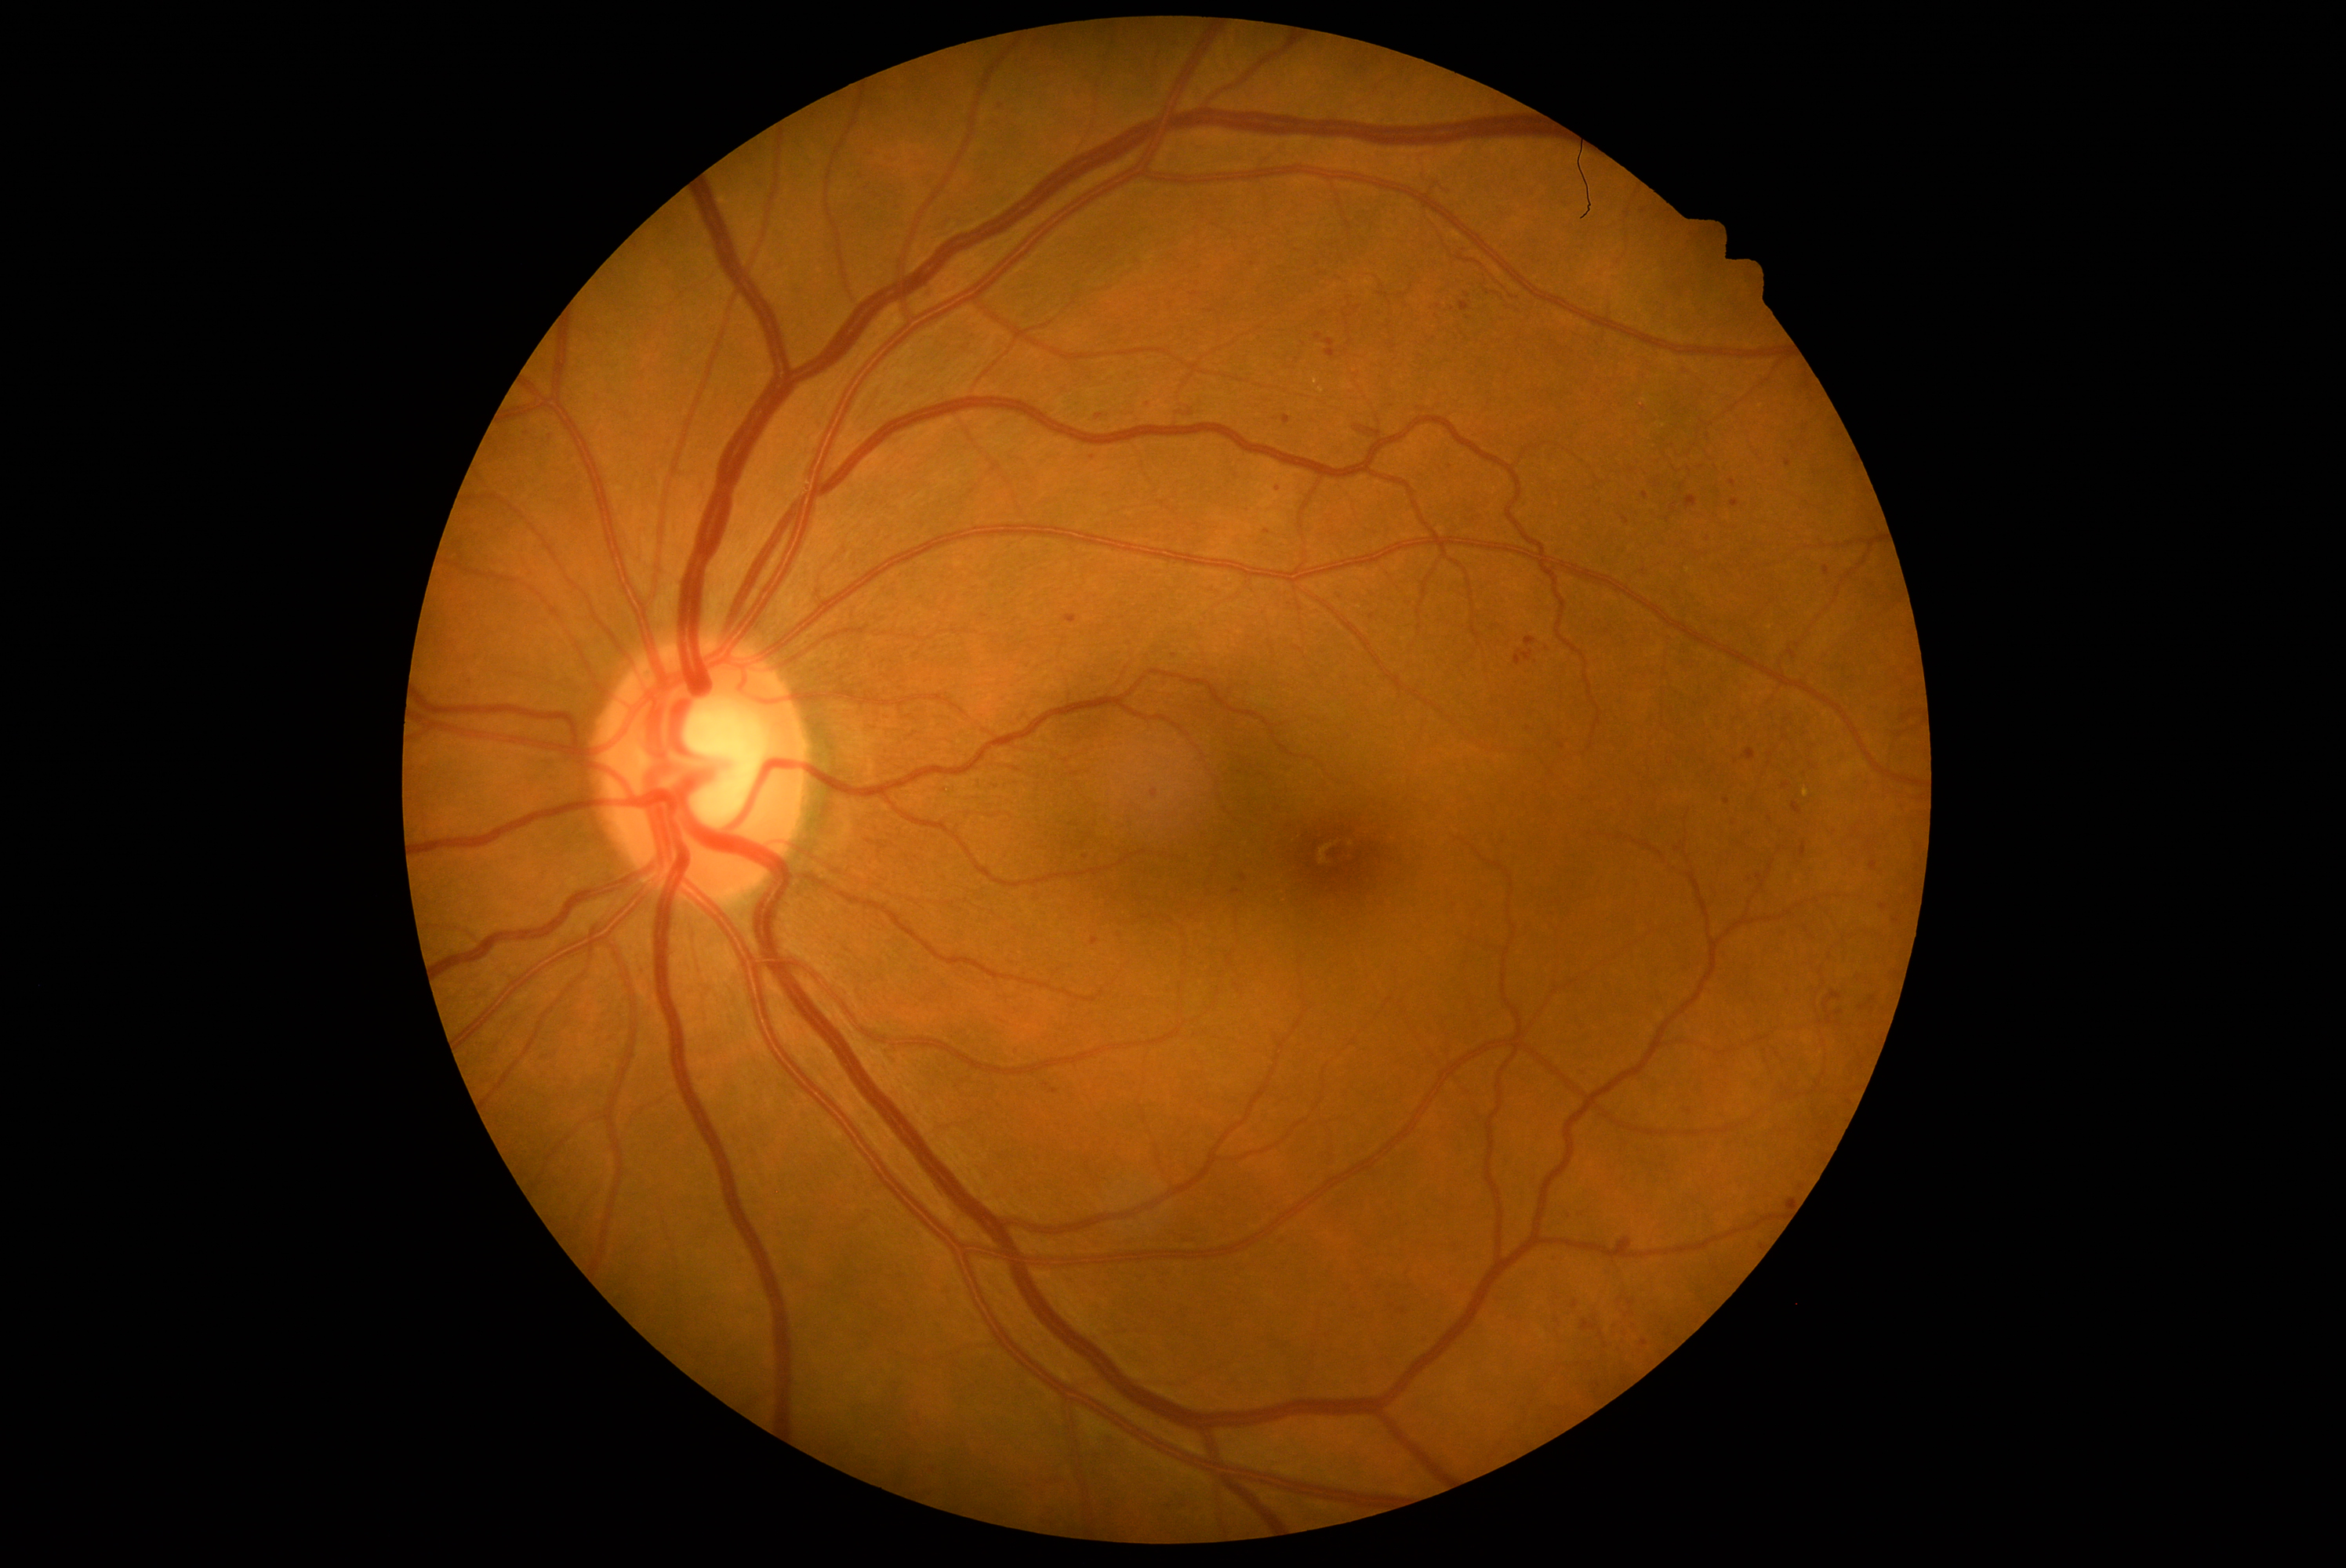 <lesions partial="true">
  <dr_grade>2</dr_grade>
  <ma partial="true">box(1789, 648, 1798, 661), box(923, 1462, 940, 1479), box(1716, 946, 1732, 960), box(1459, 302, 1470, 313), box(1091, 938, 1100, 946), box(1672, 841, 1683, 854), box(1495, 313, 1509, 325), box(1687, 496, 1698, 510), box(1284, 416, 1291, 424), box(1042, 1083, 1050, 1089), box(1778, 826, 1787, 837)</ma>
  <ma_small_centers><pt>1487,293</pt>, <pt>1620,1300</pt>, <pt>1275,419</pt>, <pt>1645,1343</pt>, <pt>1839,1013</pt>, <pt>1467,294</pt>, <pt>1100,418</pt>, <pt>1708,437</pt></ma_small_centers>
</lesions>